FOV: 45 degrees: 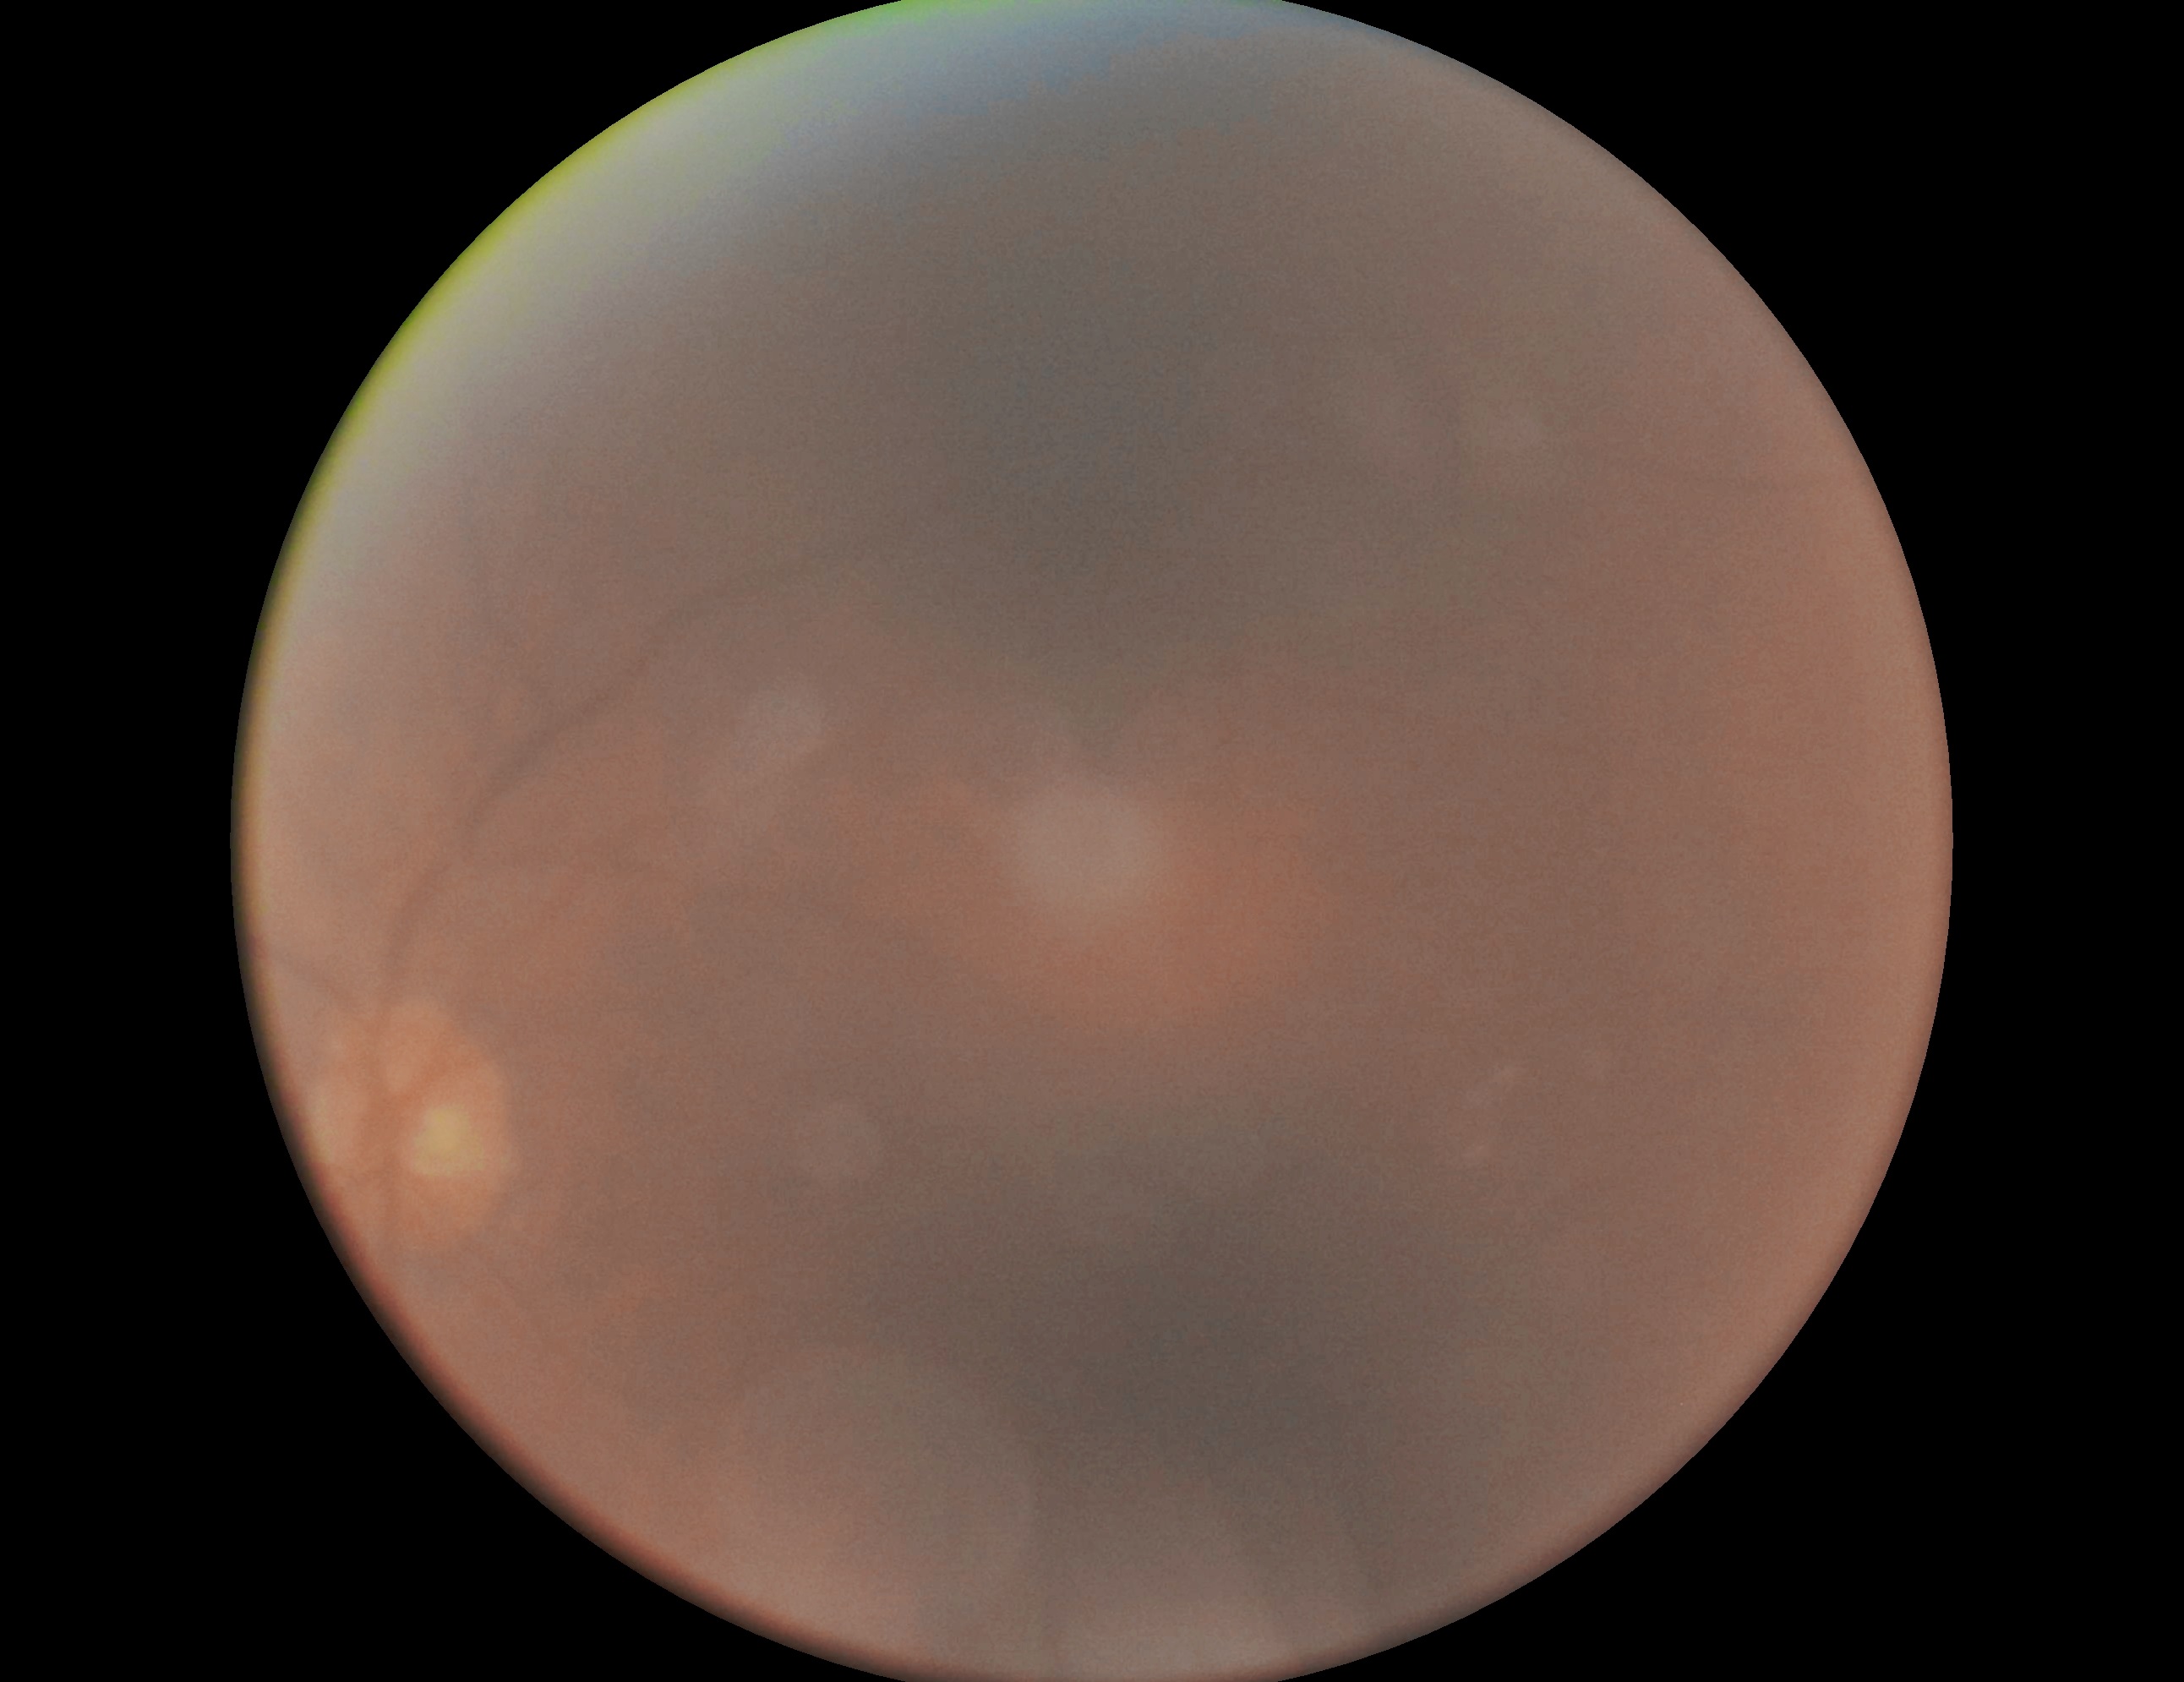
Image quality is insufficient for diabetic retinopathy assessment. Diabetic retinopathy: ungradable due to poor image quality.